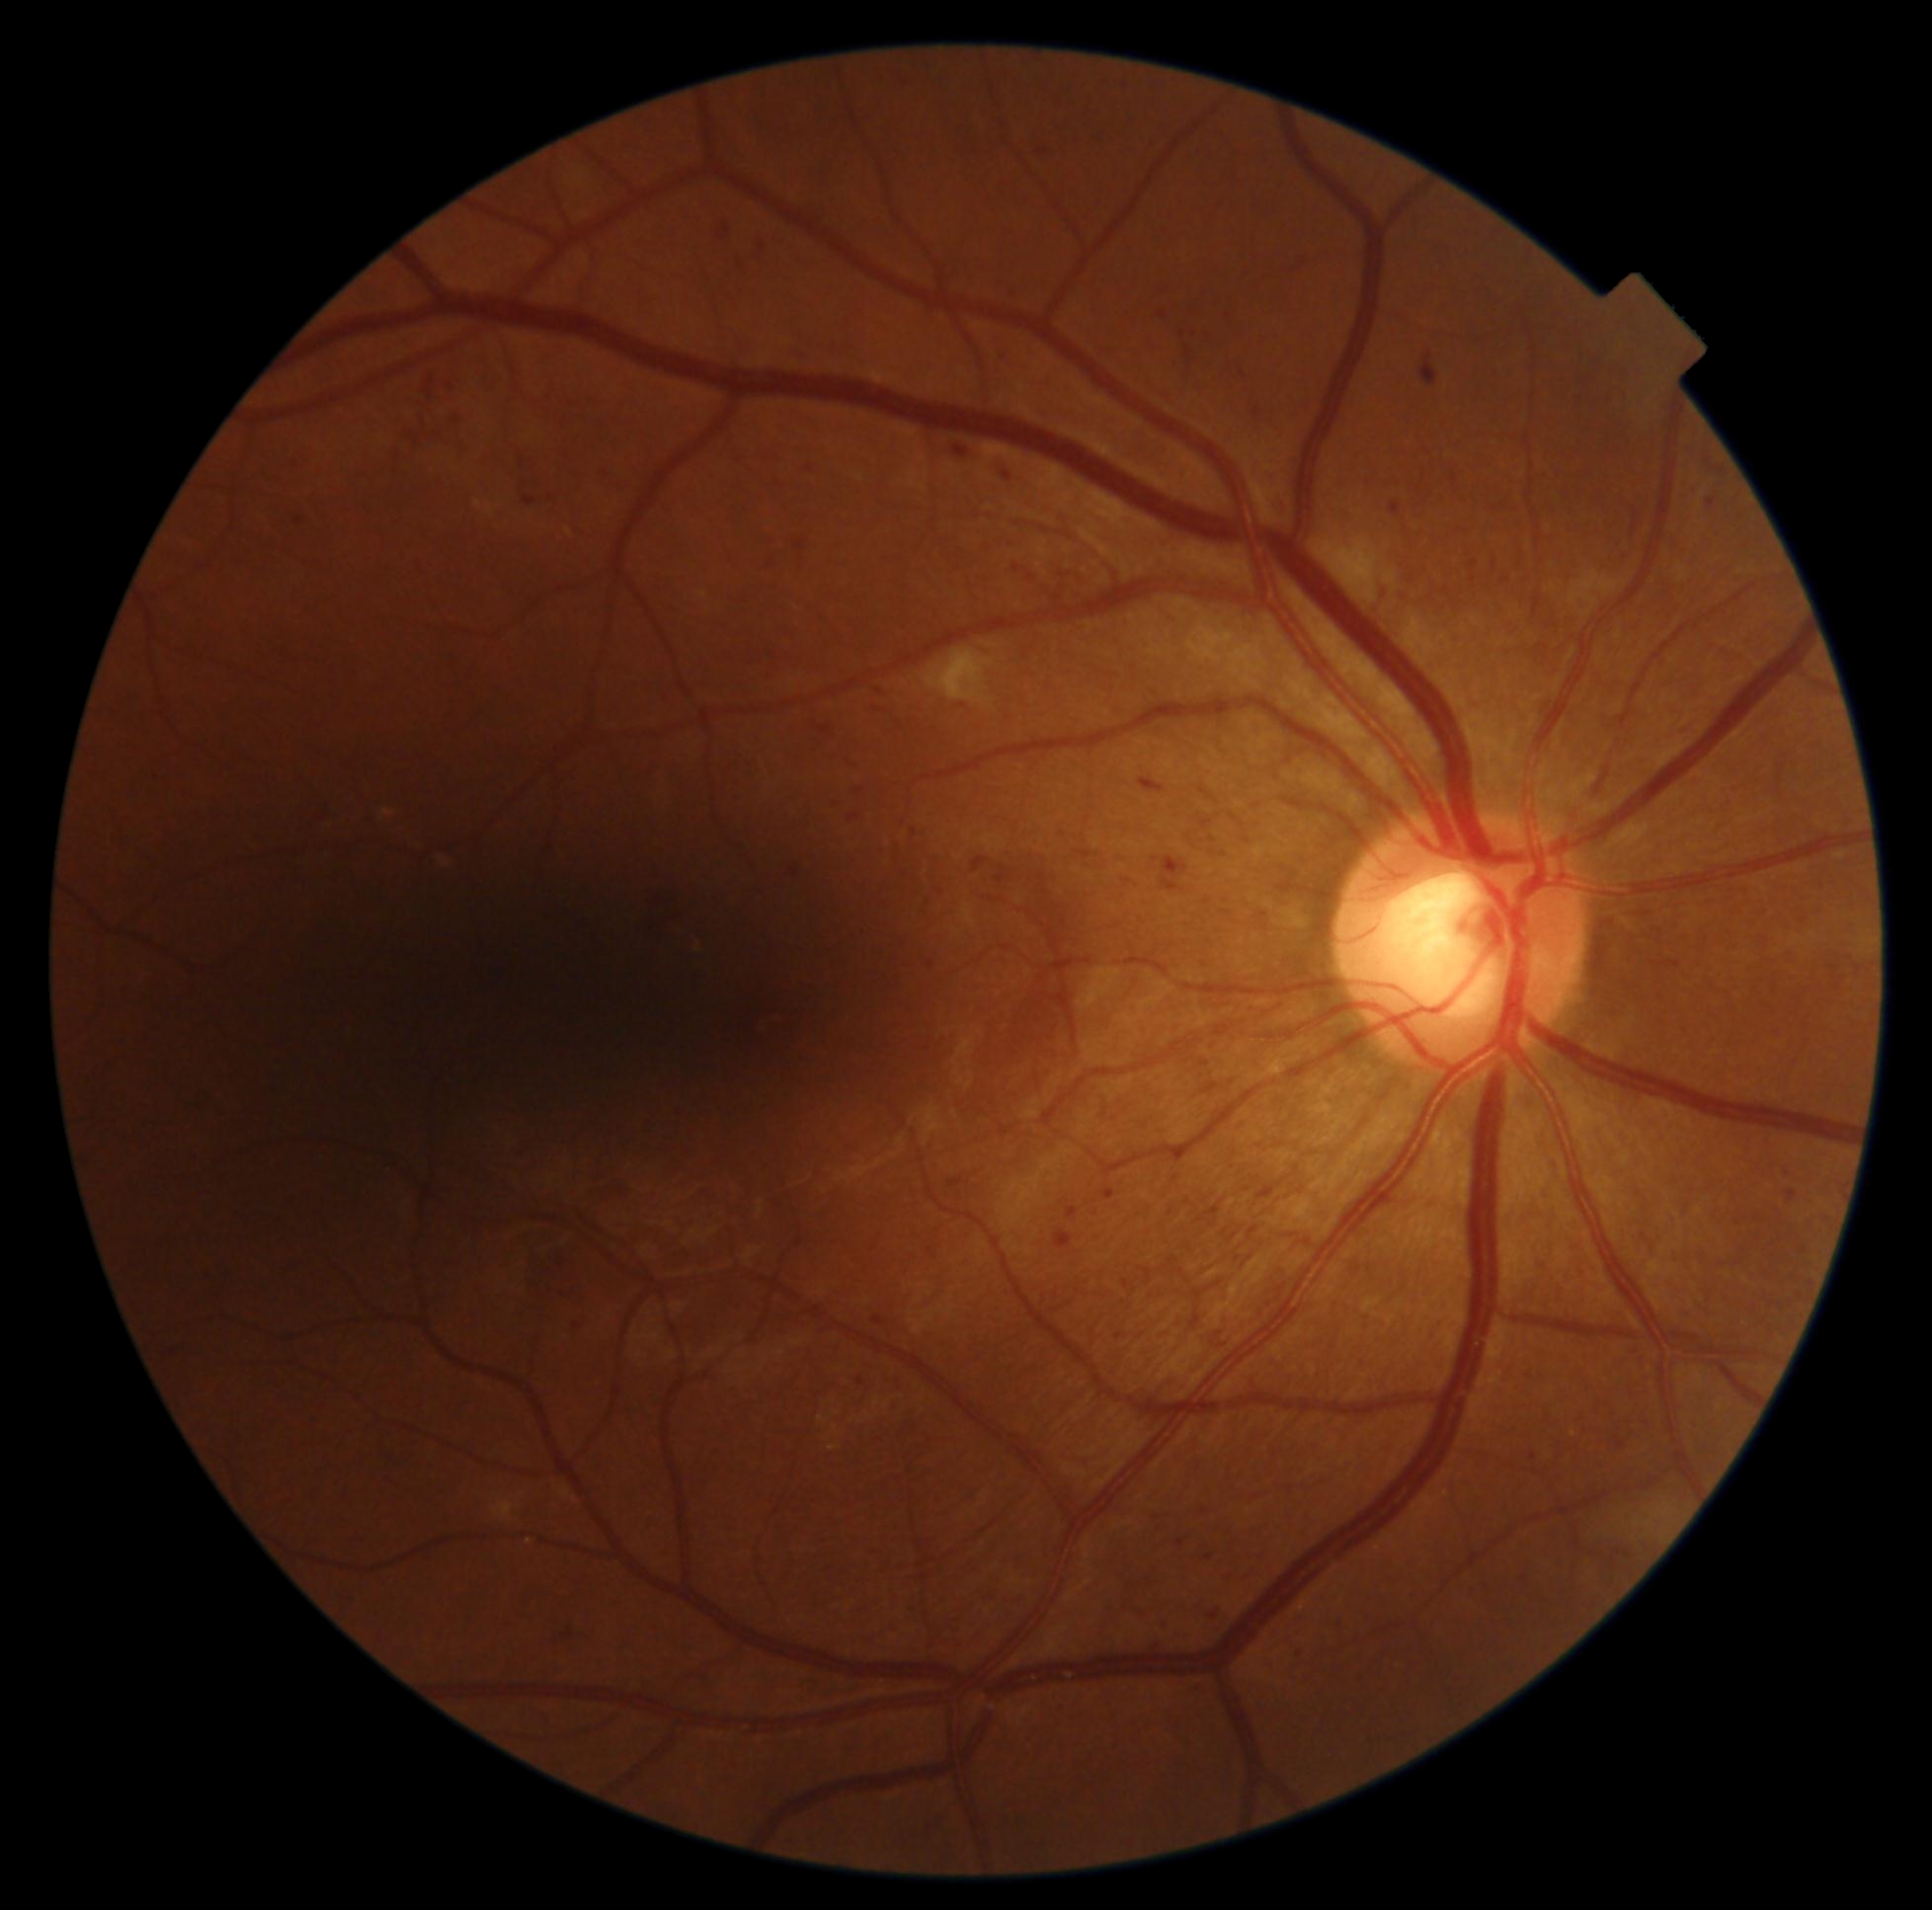
Diabetic retinopathy (DR) is 2/4; non-proliferative diabetic retinopathy
A subset of detected lesions:
microaneurysms (MAs) (subset): BBox(768, 561, 775, 569) | BBox(912, 830, 919, 838) | BBox(1530, 1453, 1537, 1461) | BBox(1013, 565, 1022, 574) | BBox(1786, 1190, 1799, 1202) | BBox(523, 495, 537, 508) | BBox(1068, 1208, 1079, 1221) | BBox(1708, 499, 1718, 510) | BBox(716, 224, 731, 241) | BBox(1202, 1082, 1220, 1095) | BBox(1139, 778, 1167, 794) | BBox(408, 433, 421, 446)
Additional small MAs near x=774, y=655 | x=1233, y=1083 | x=1161, y=695 | x=1205, y=1511